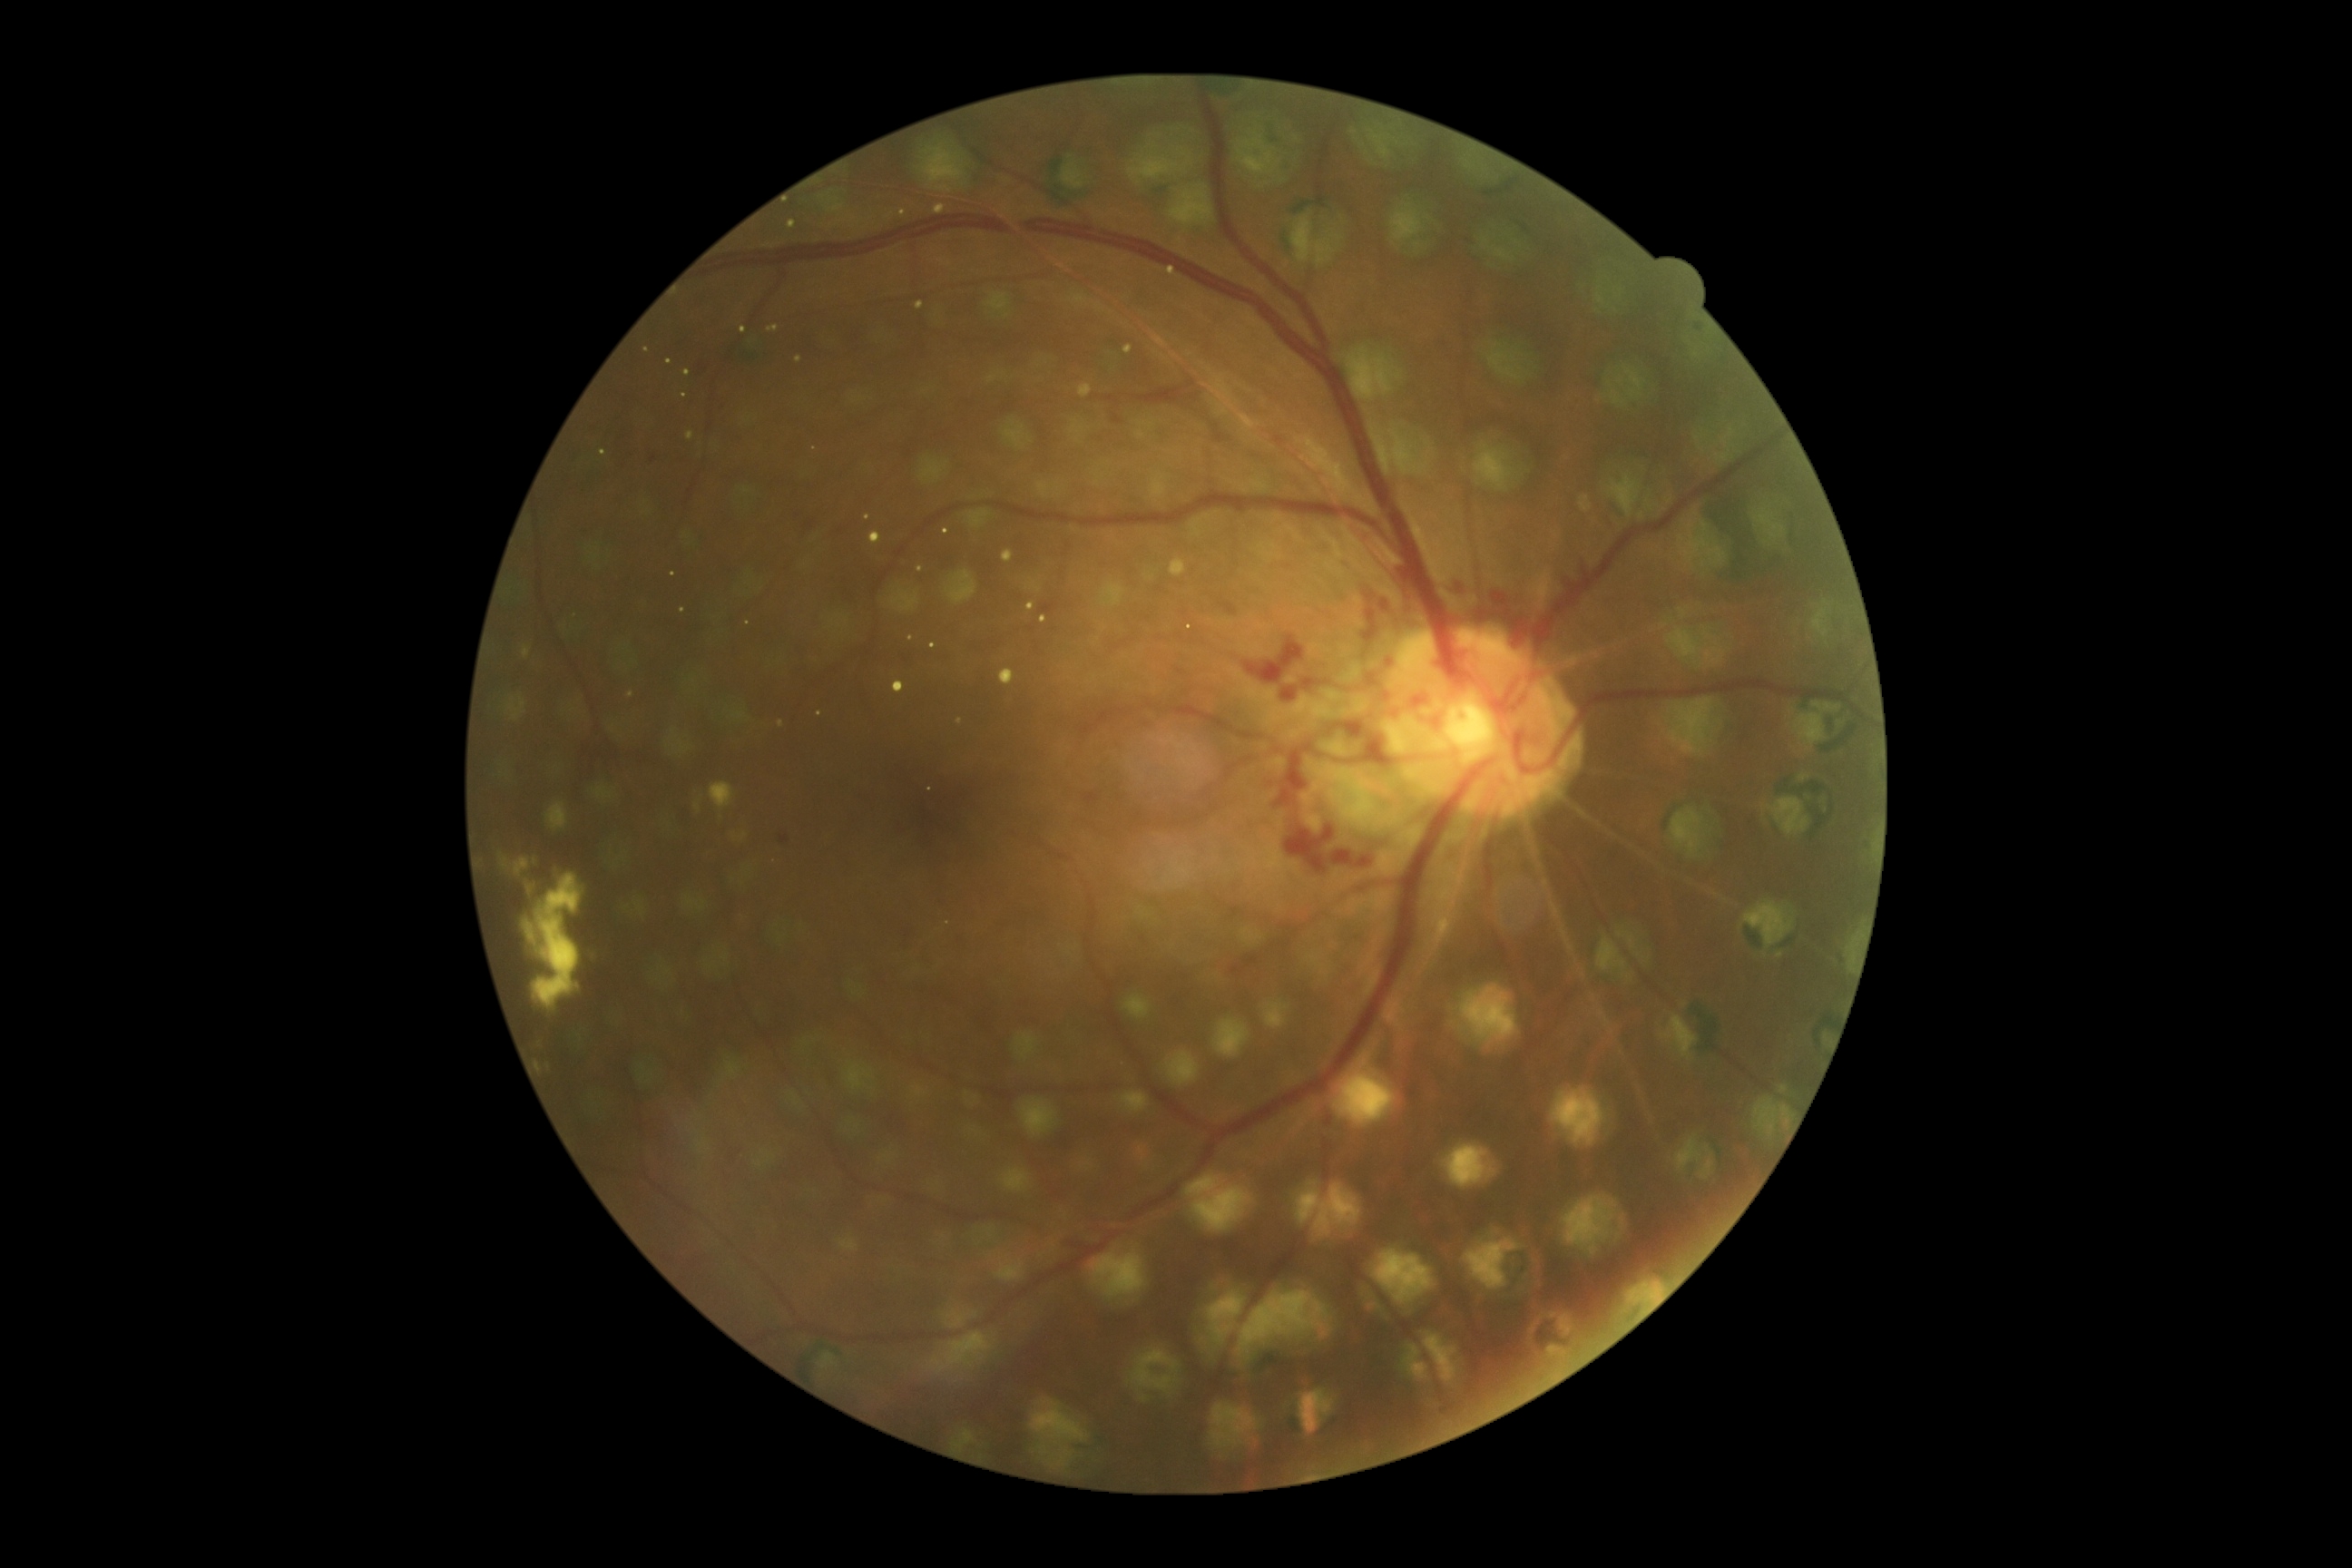 Diabetic retinopathy (DR) is grade 4 (PDR).